45-degree field of view; no pharmacologic dilation: 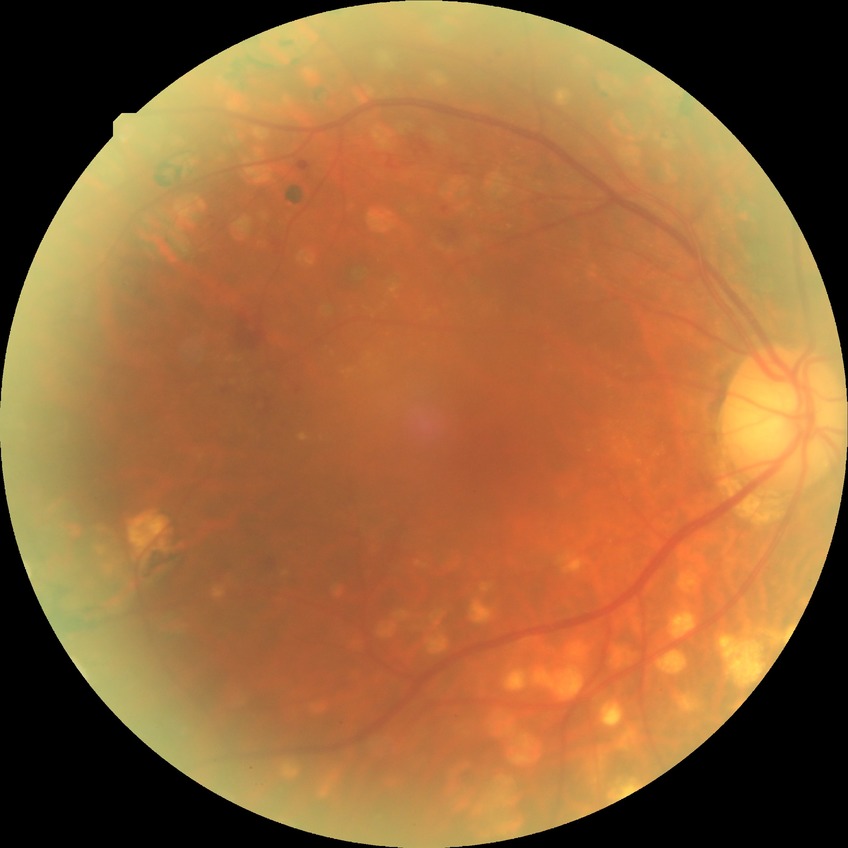

davis_grade: PDR